1659 by 2212 pixels · color fundus photograph · camera: Remidio FOP fundus camera — 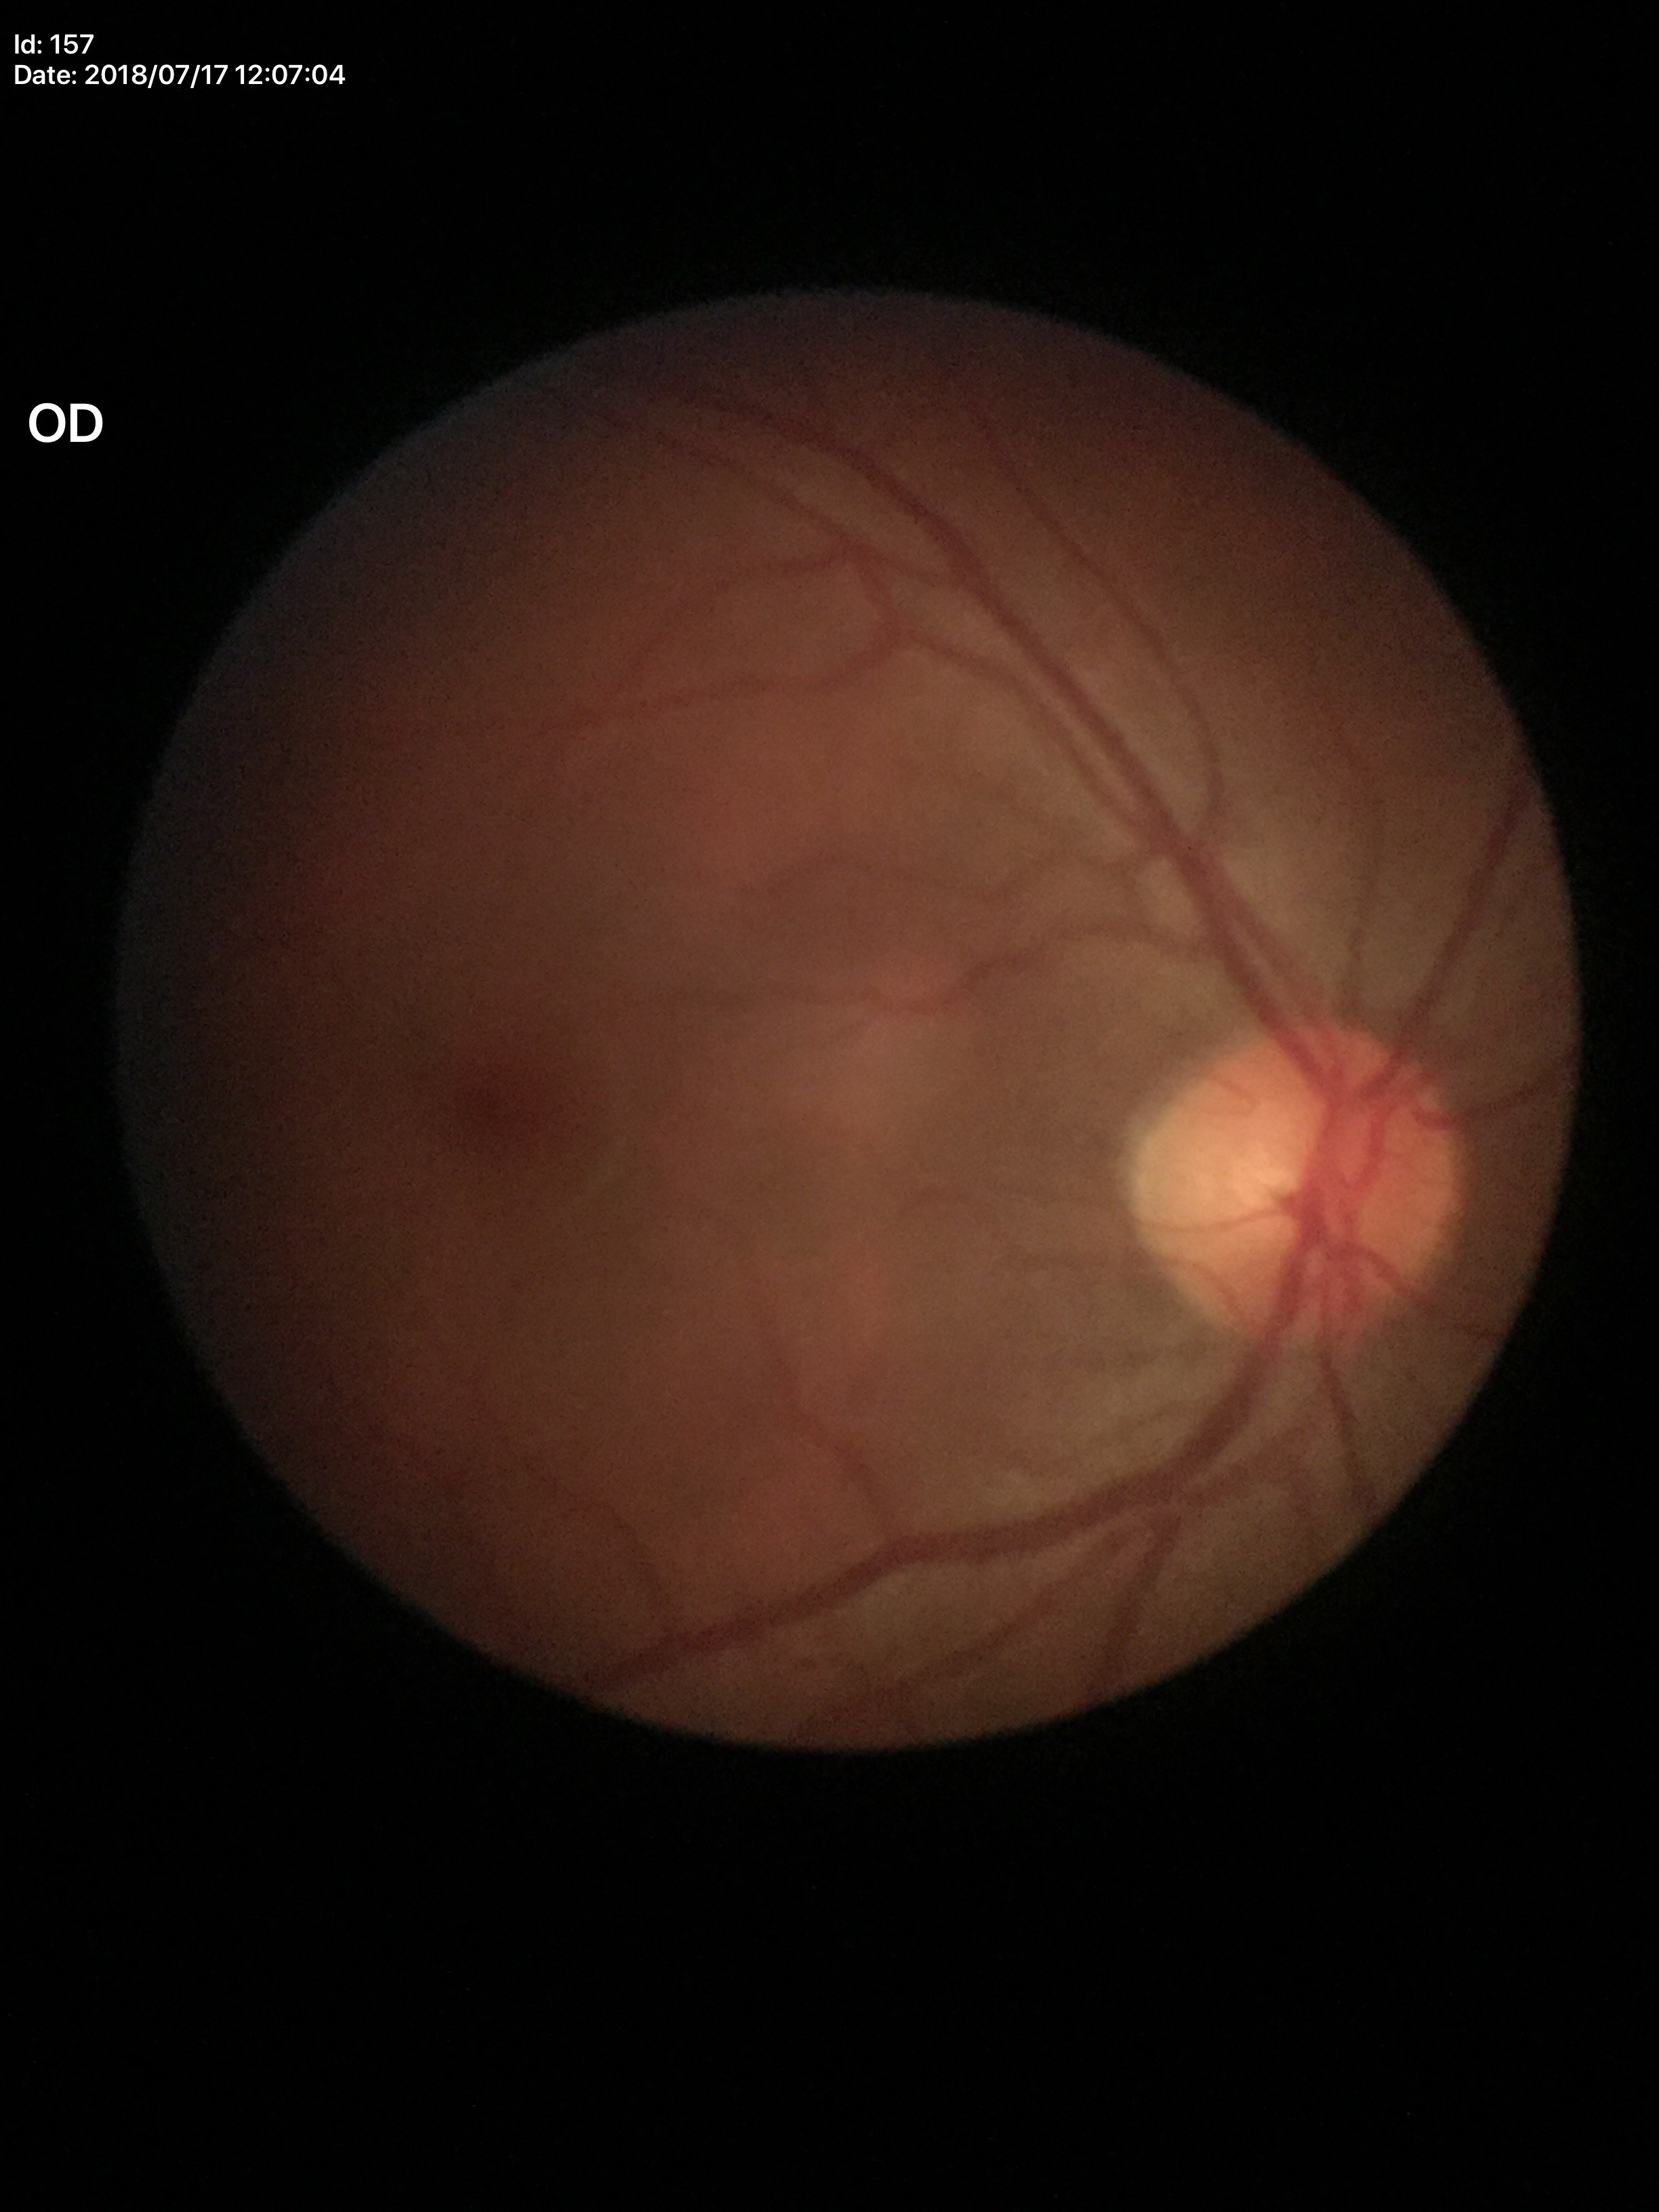

glaucoma_decision: not suspect
vcdr: 0.45
hcdr: 0.44